Non-mydriatic acquisition. CFP. 240 by 240 pixels: 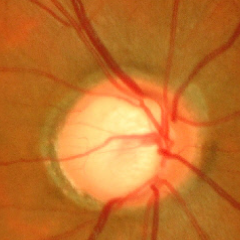

Showing severe glaucomatous damage.